CFP — 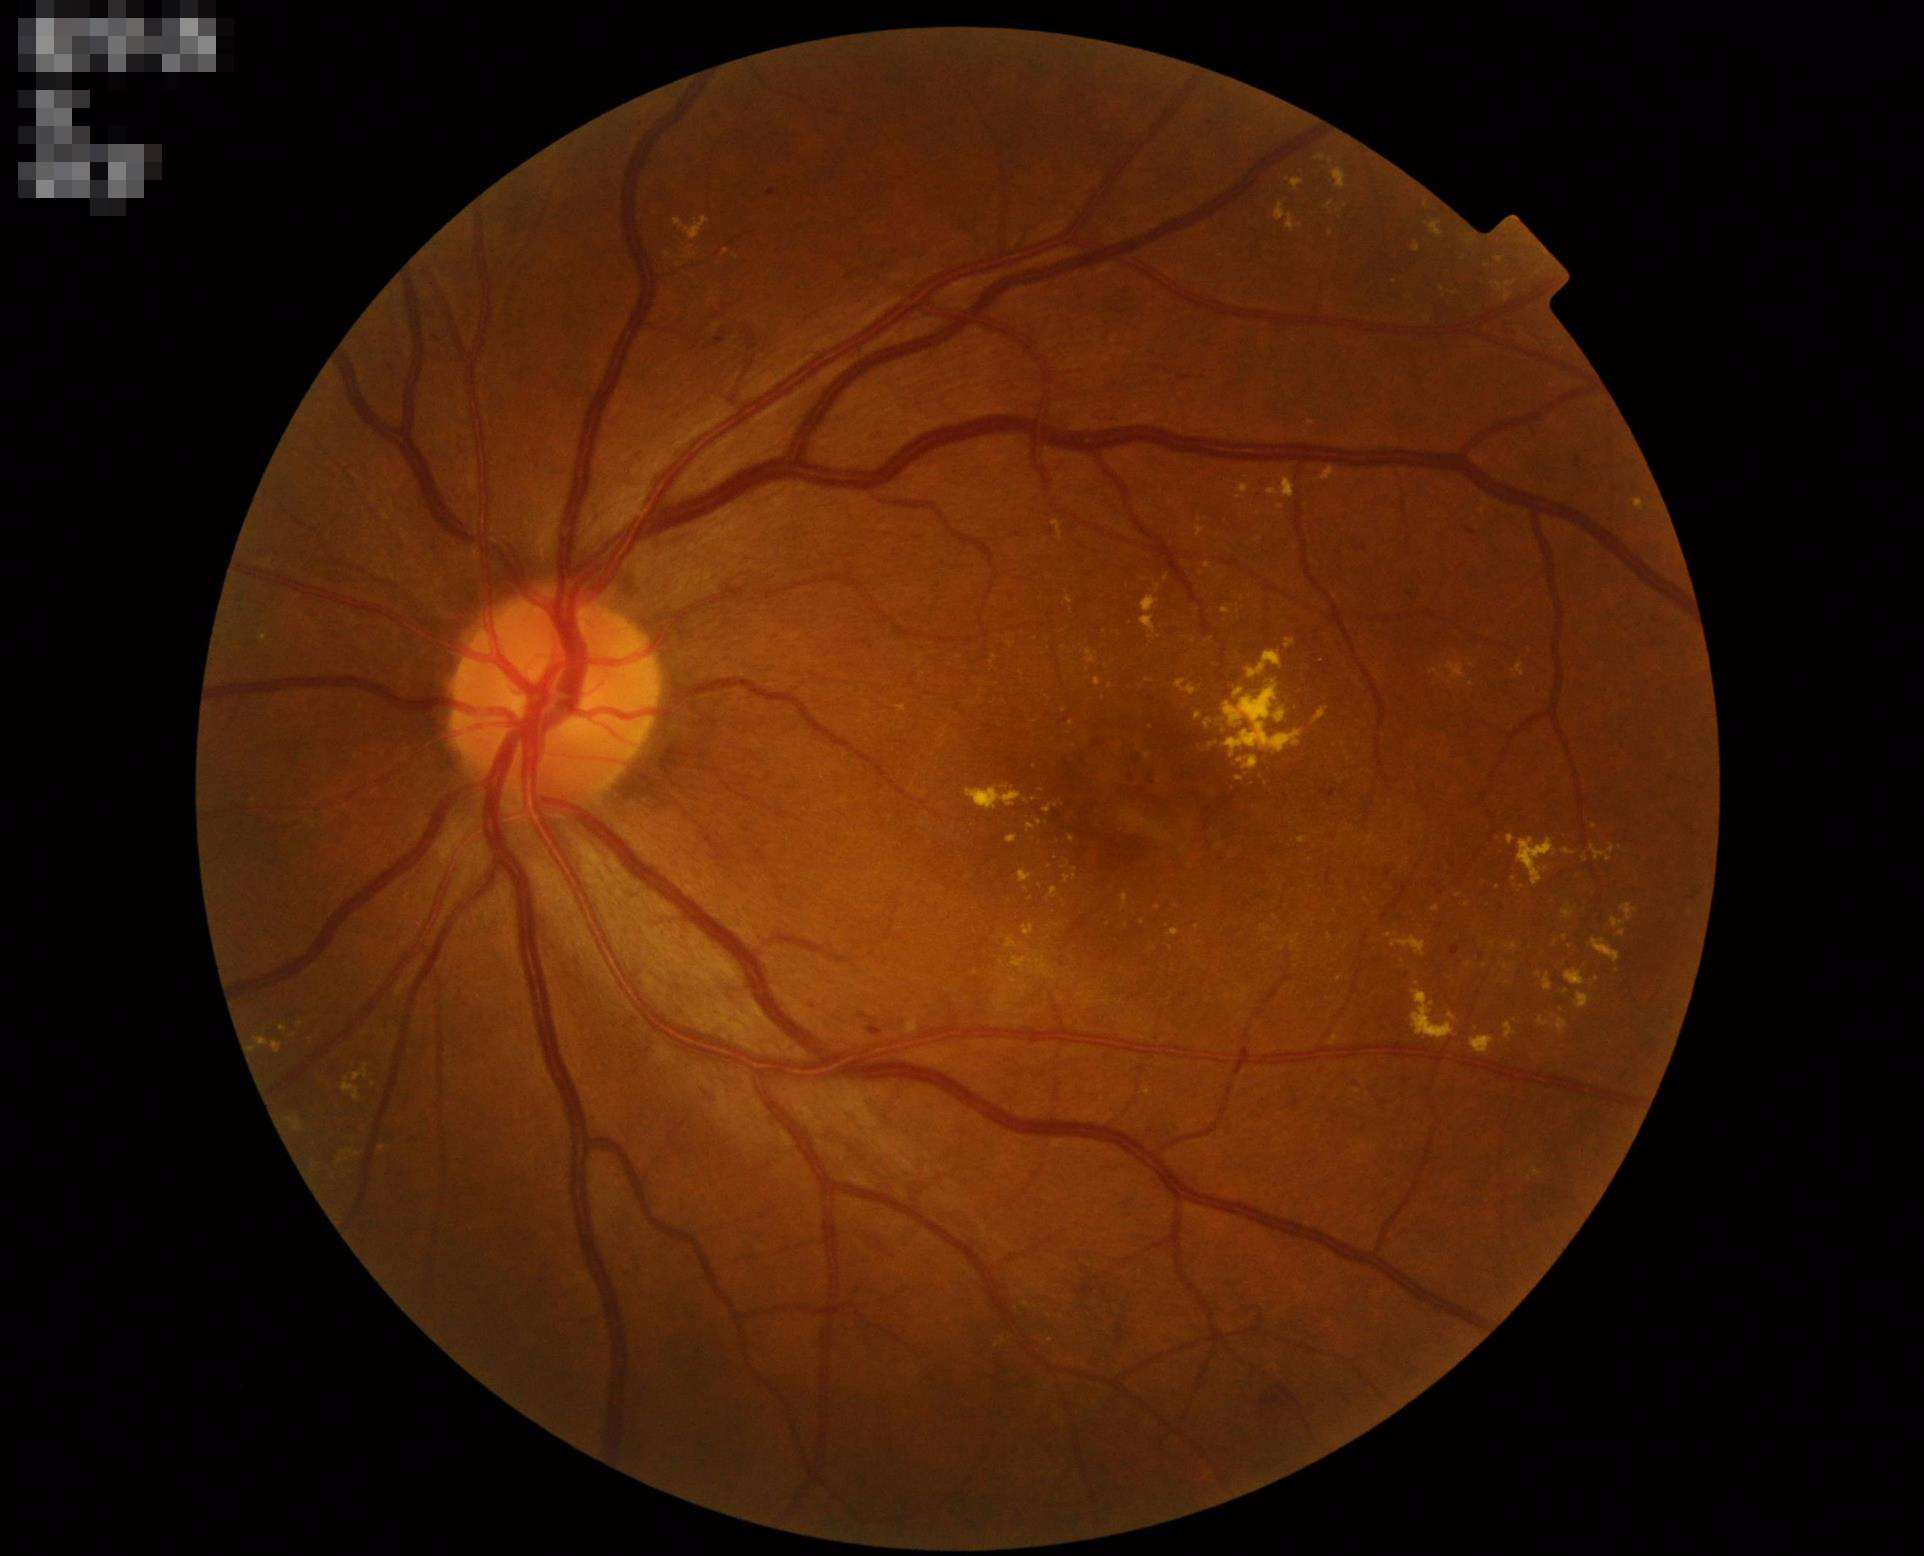

Contrast is good. Overall image quality is good. Illumination and color balance are good. Optic disc, vessels, and background are in focus.